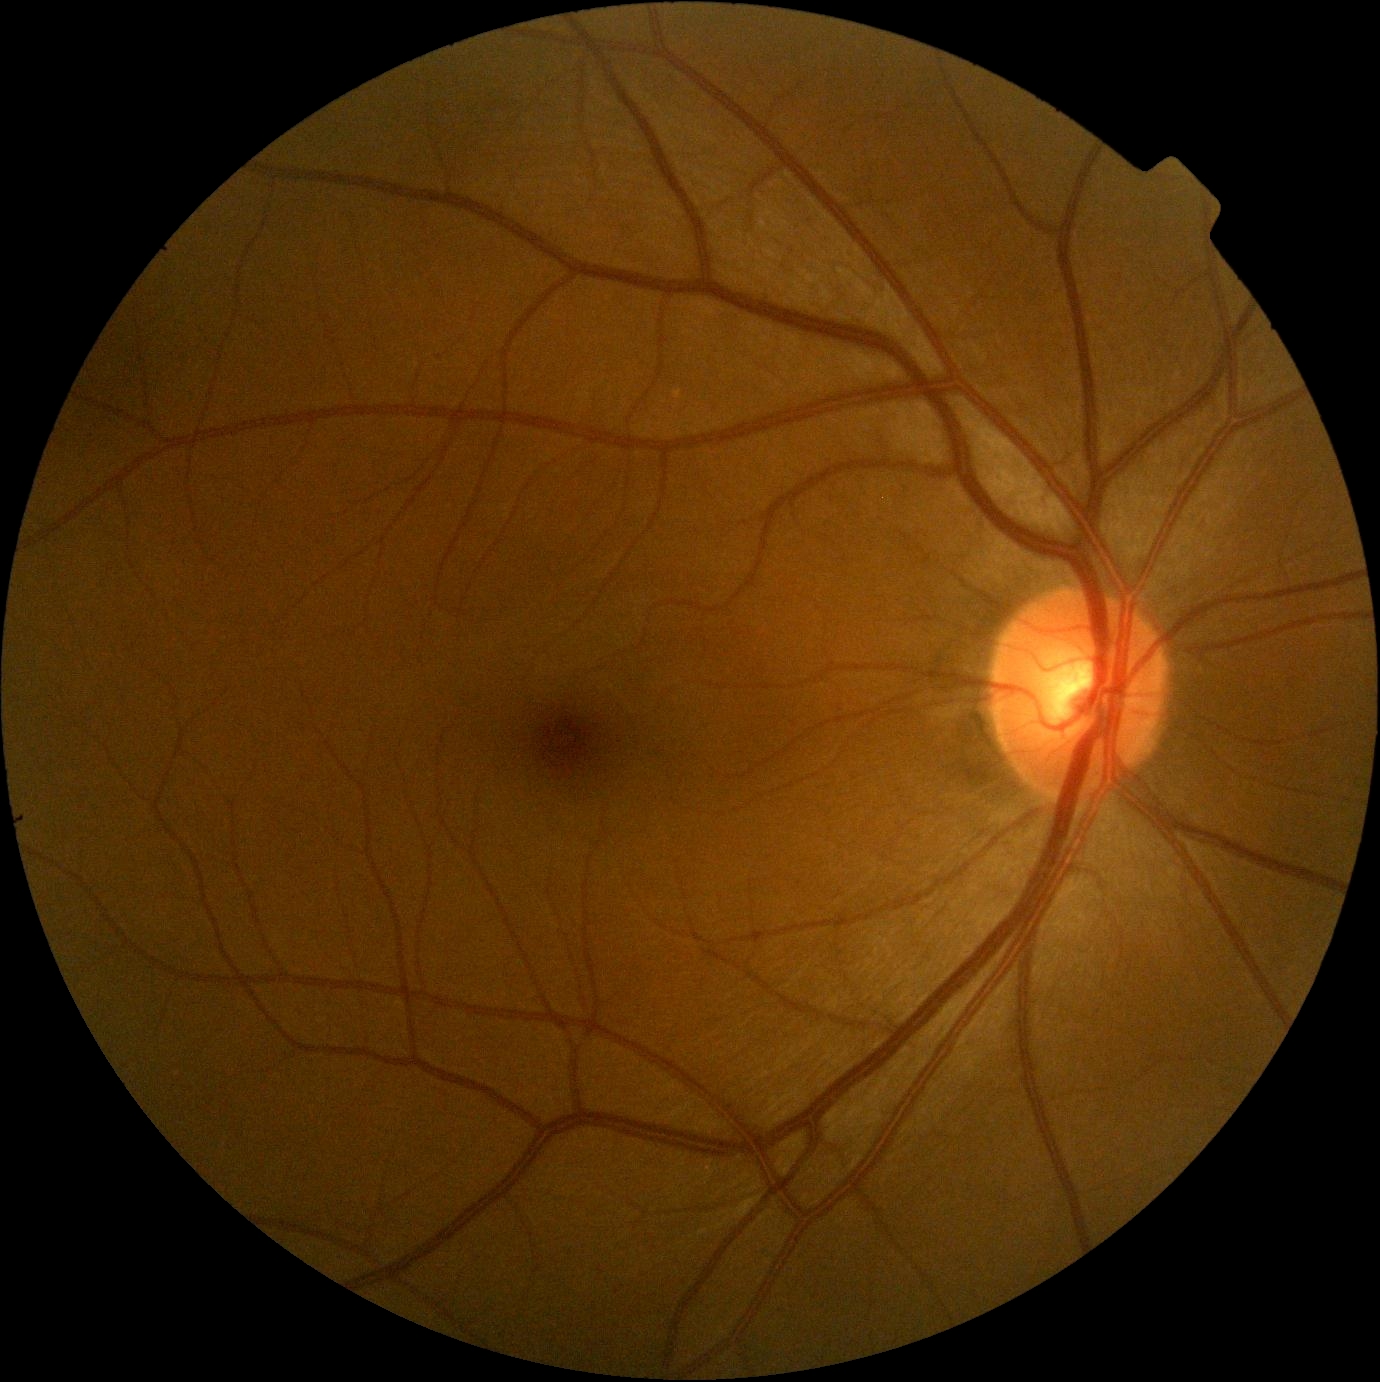

Retinopathy grade: 0/4.